FOV: 45 degrees · no pharmacologic dilation · DR severity per modified Davis staging · 848 by 848 pixels
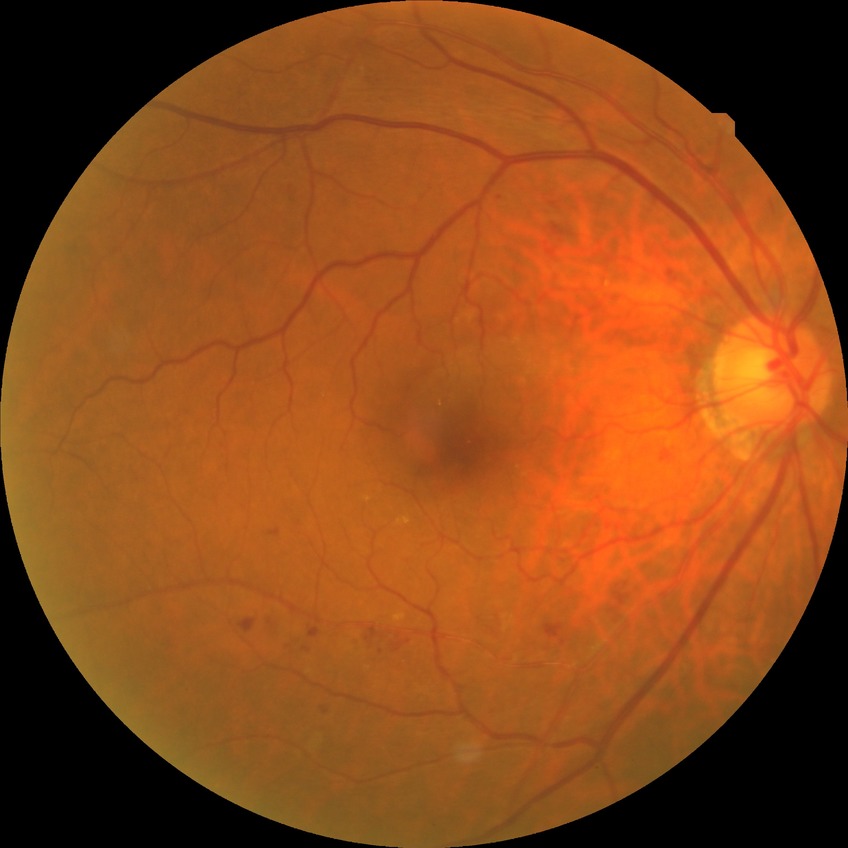
diabetic retinopathy grade = simple diabetic retinopathy; DR class = non-proliferative diabetic retinopathy.